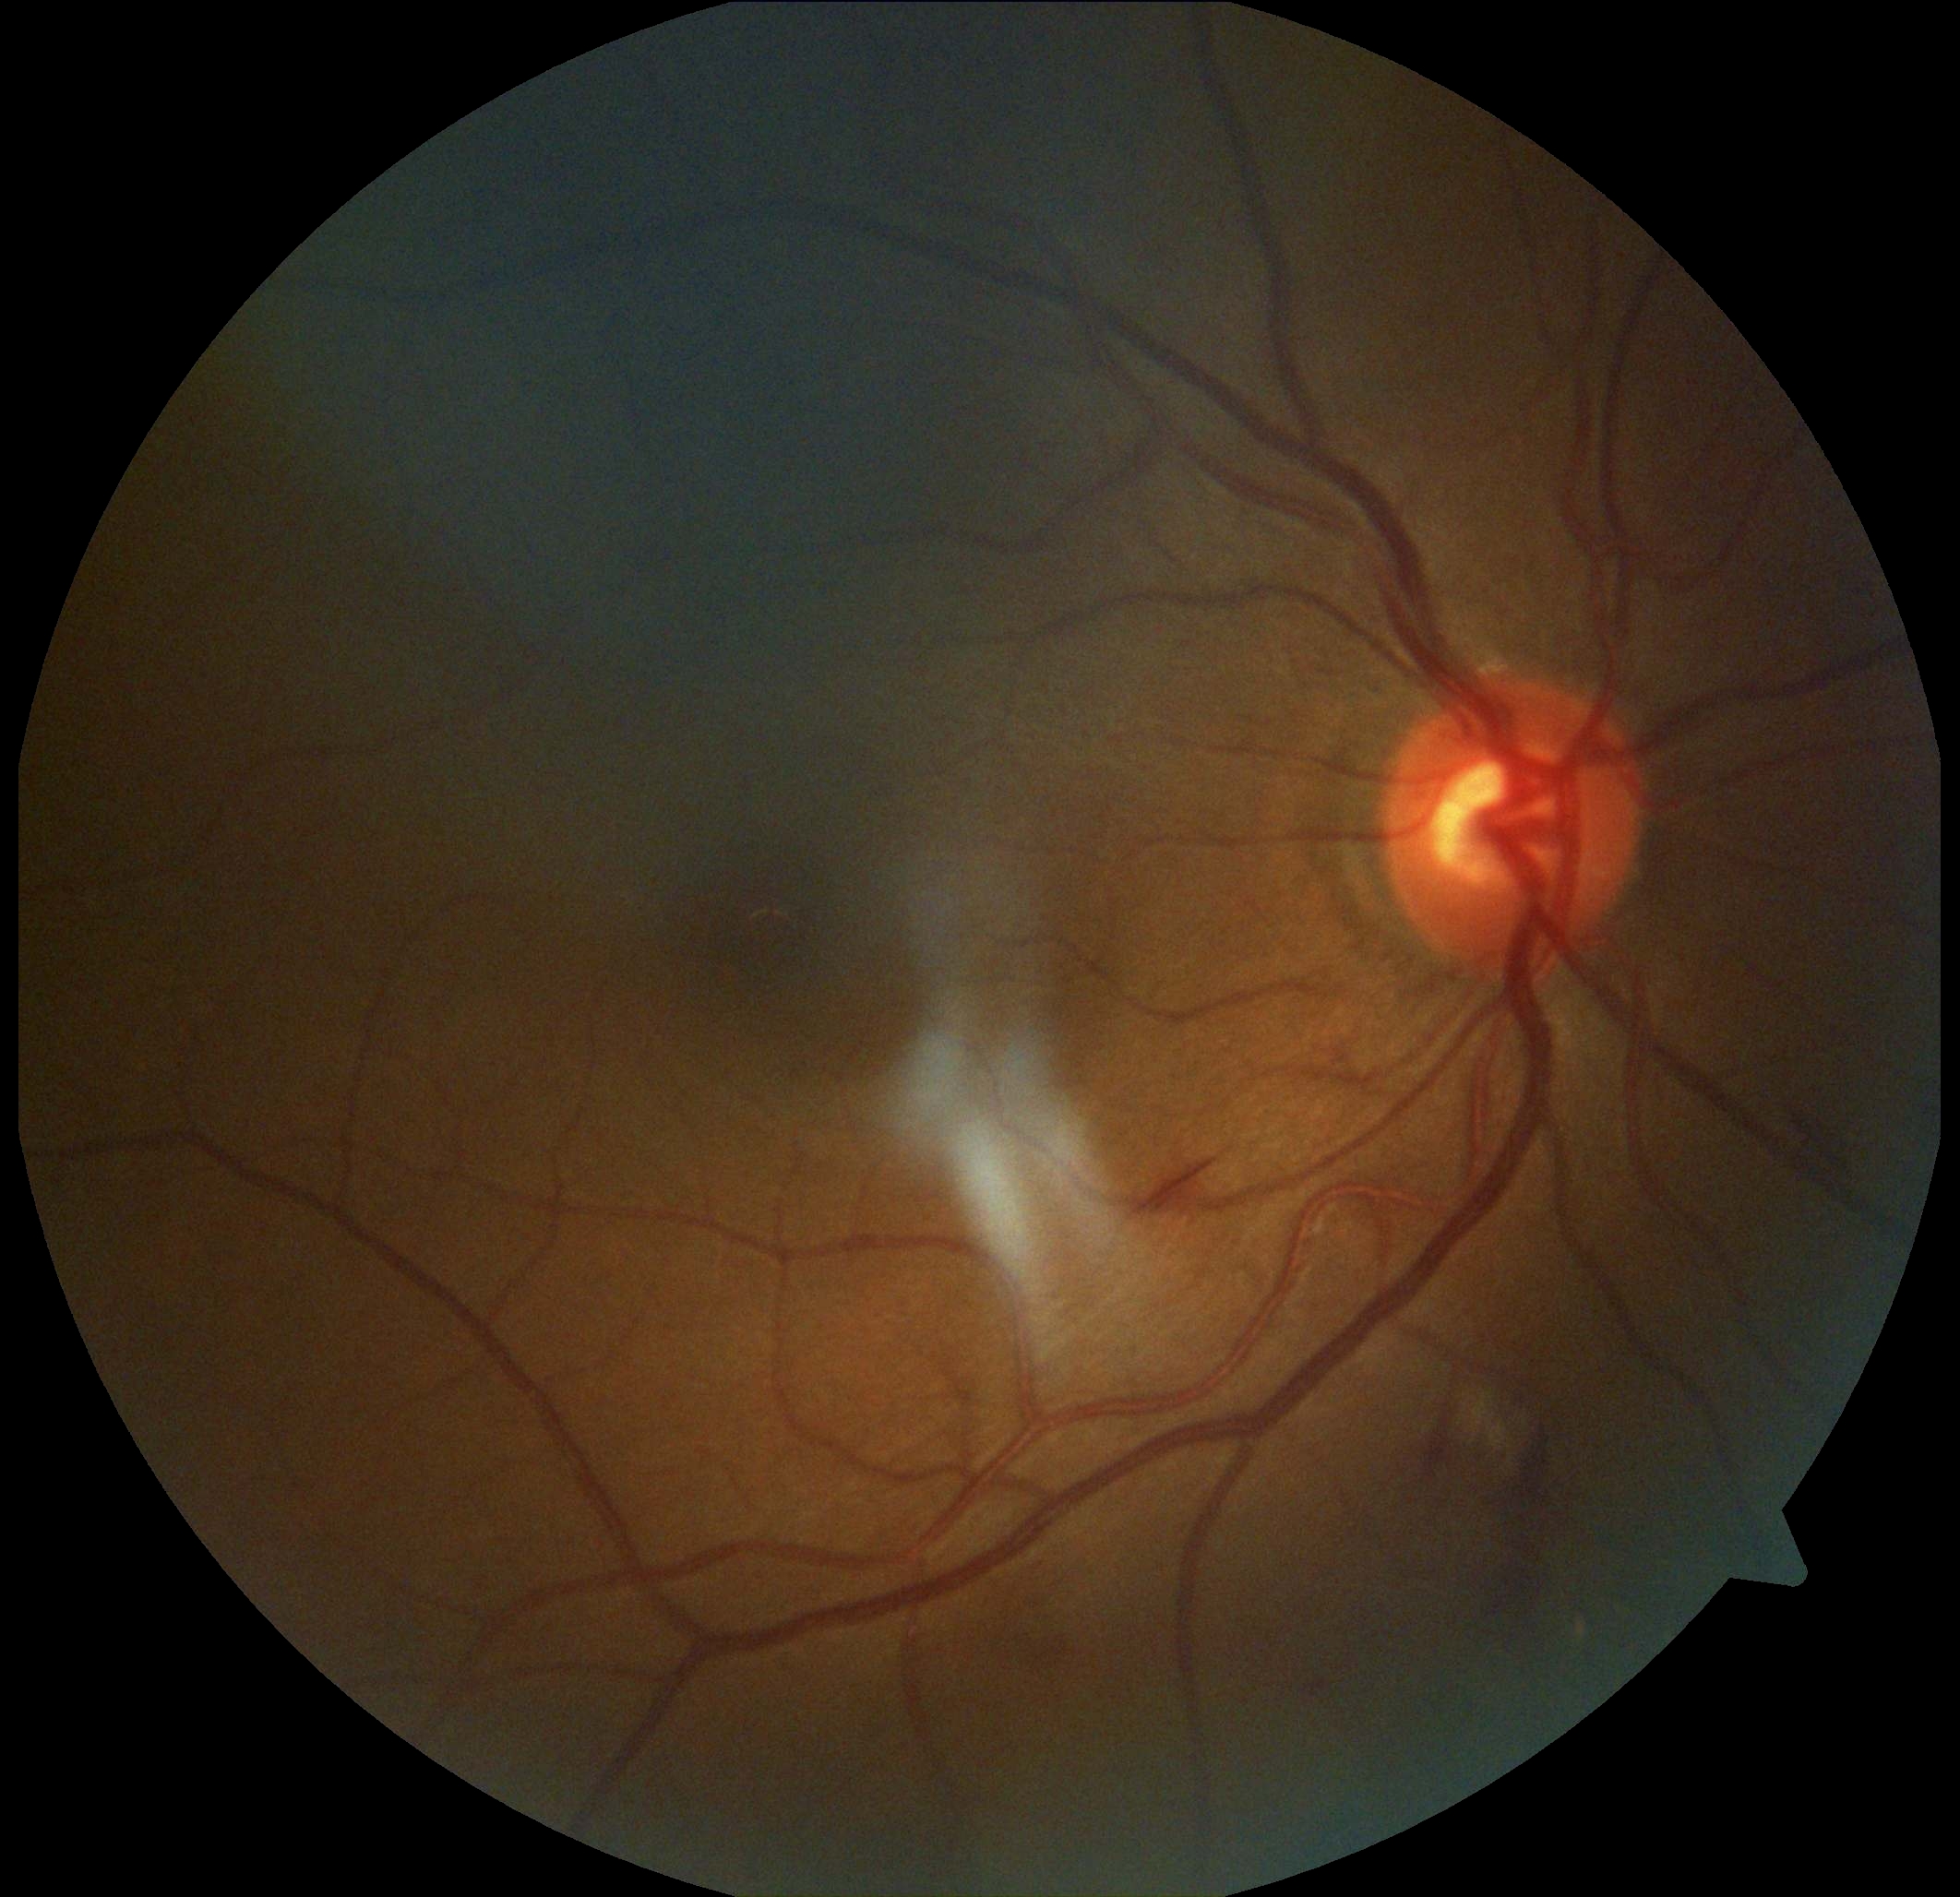 diabetic retinopathy grade = 2